1923x1932:
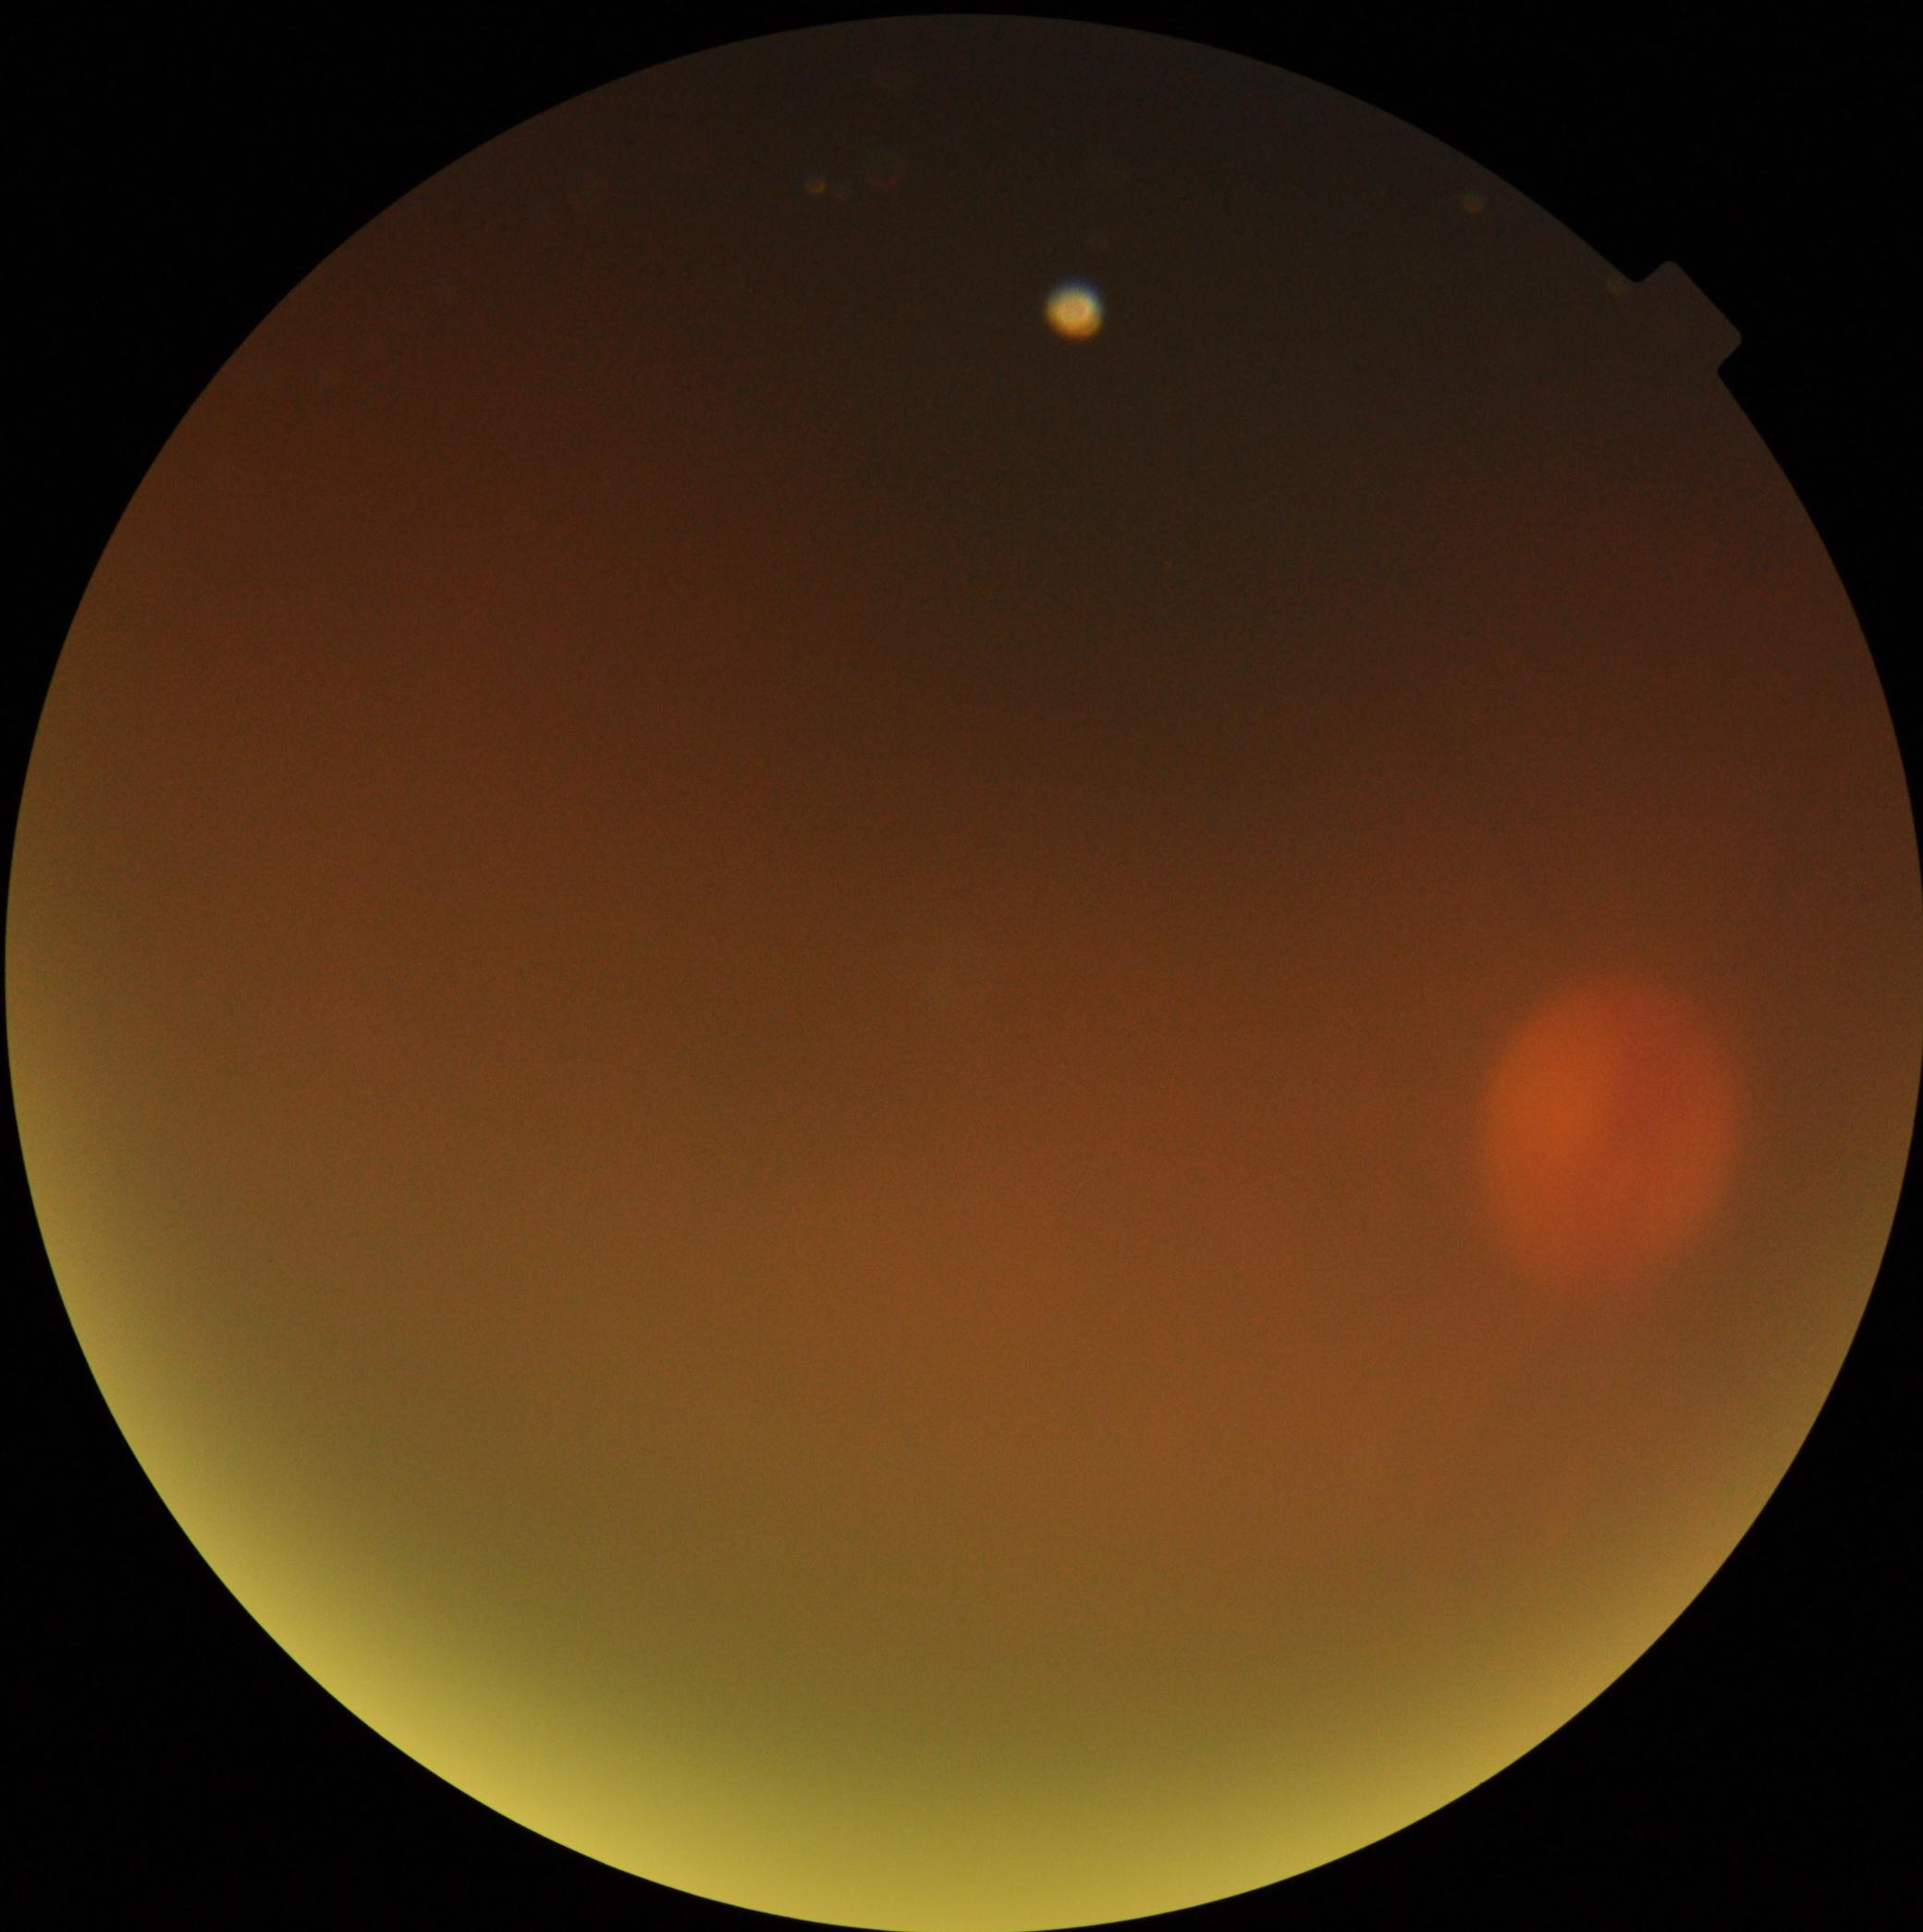

DR severity: ungradable due to poor image quality.
Image quality is insufficient for diabetic retinopathy assessment.